Color fundus image — 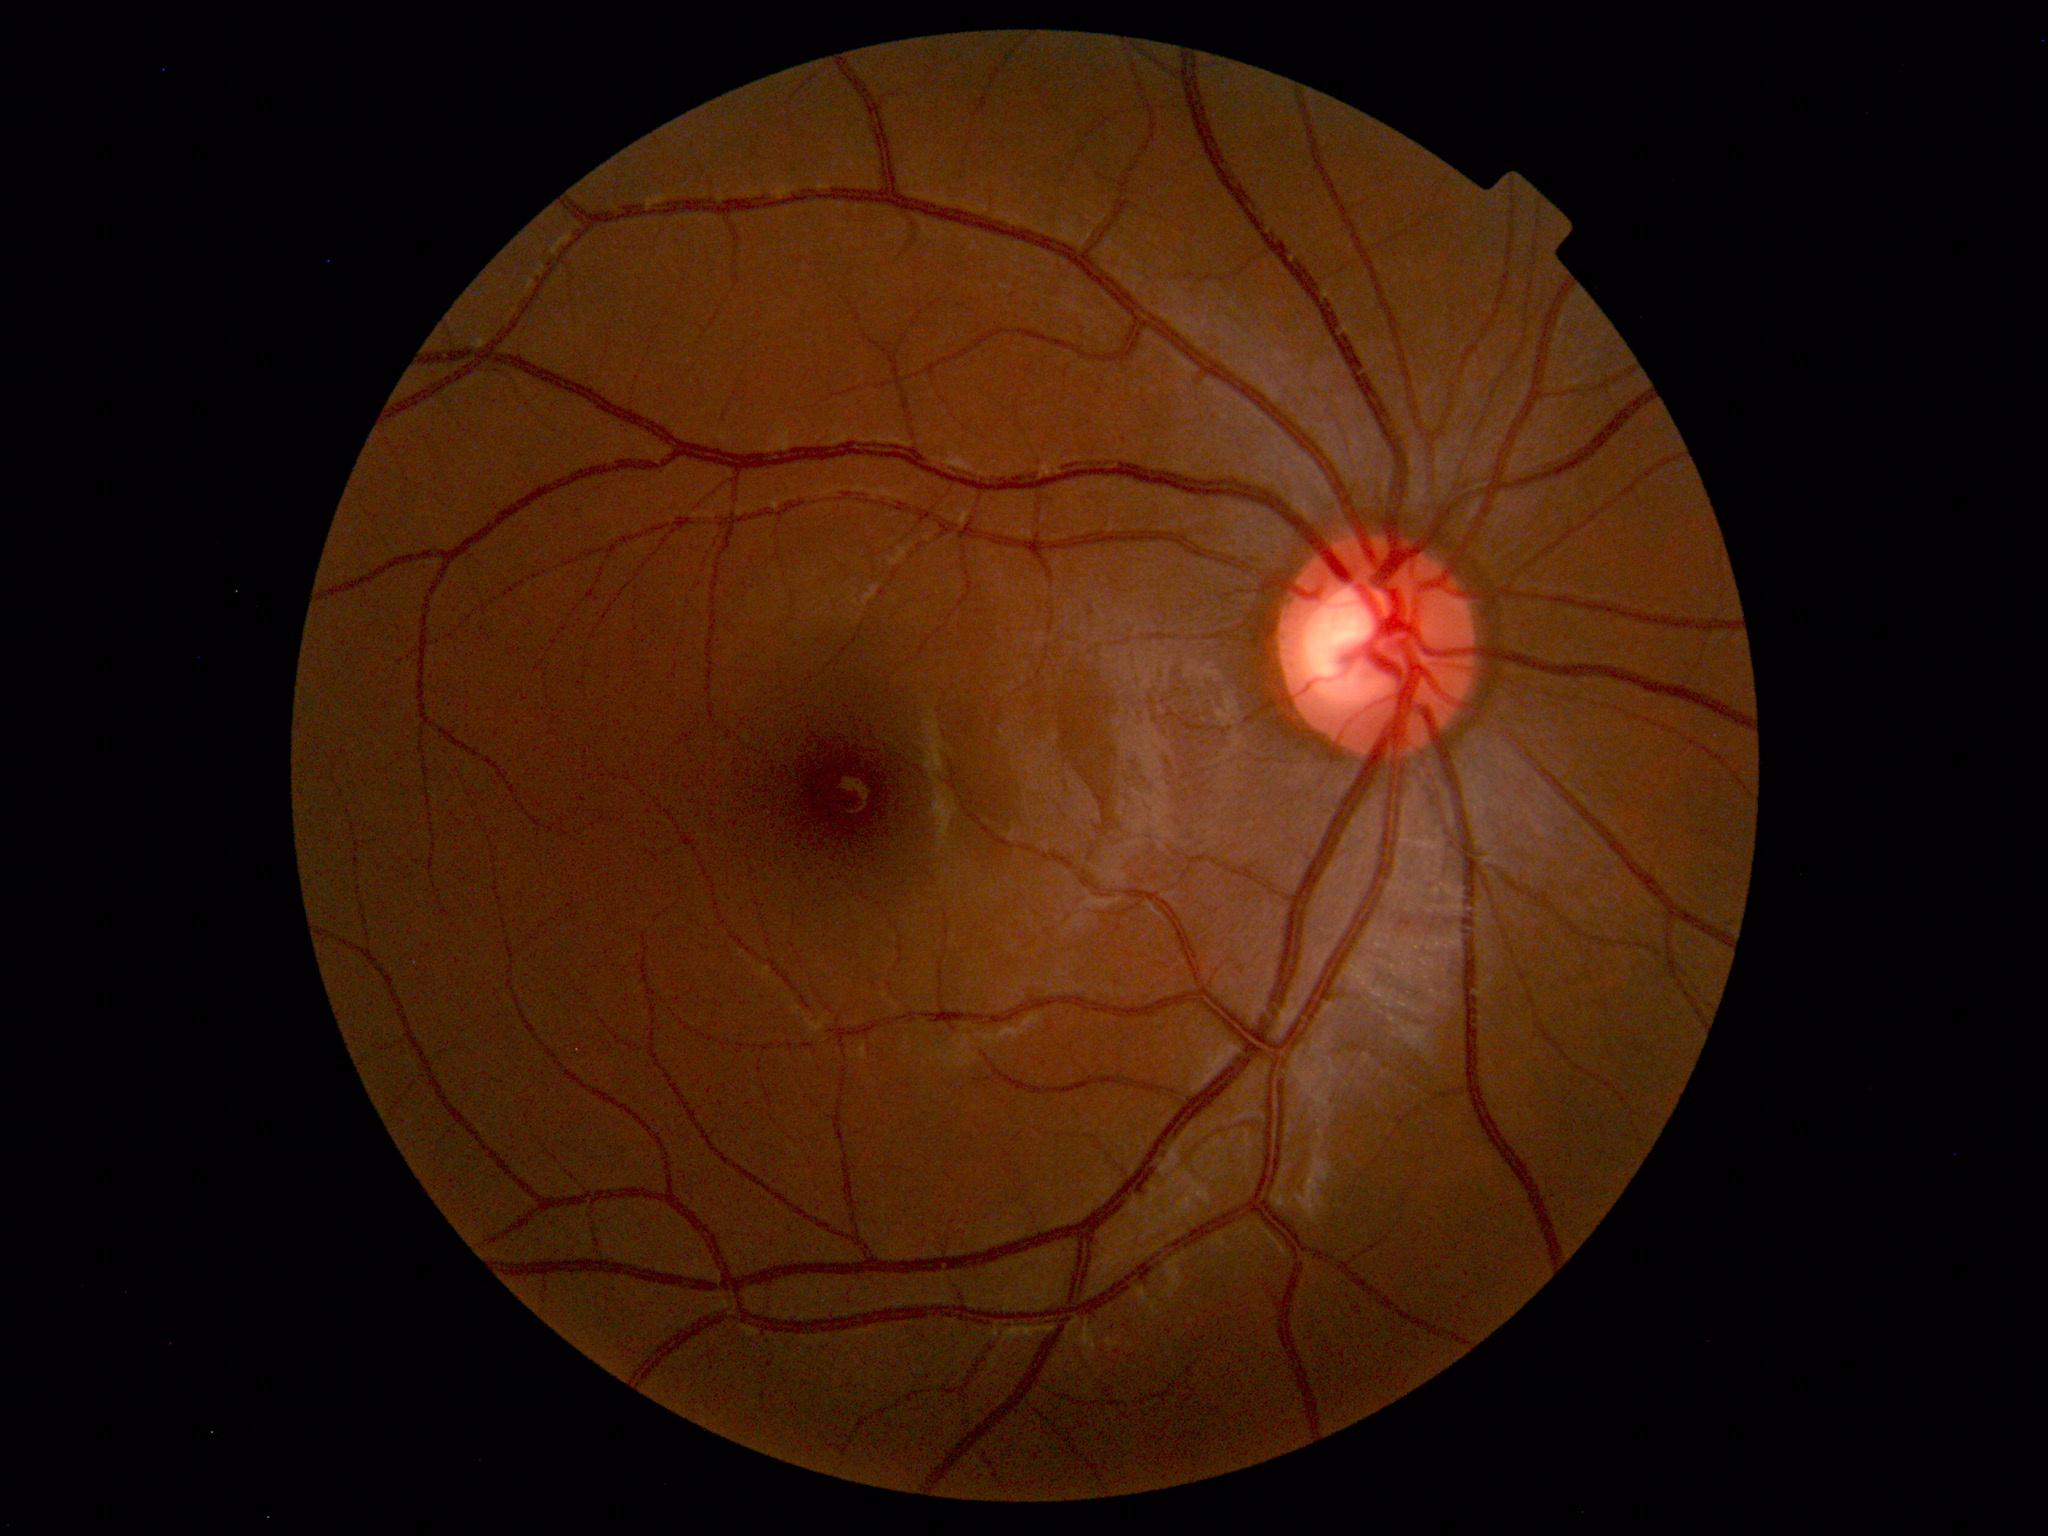

Diagnosis: normal.